Color fundus image, acquired with a NIDEK AFC-230:
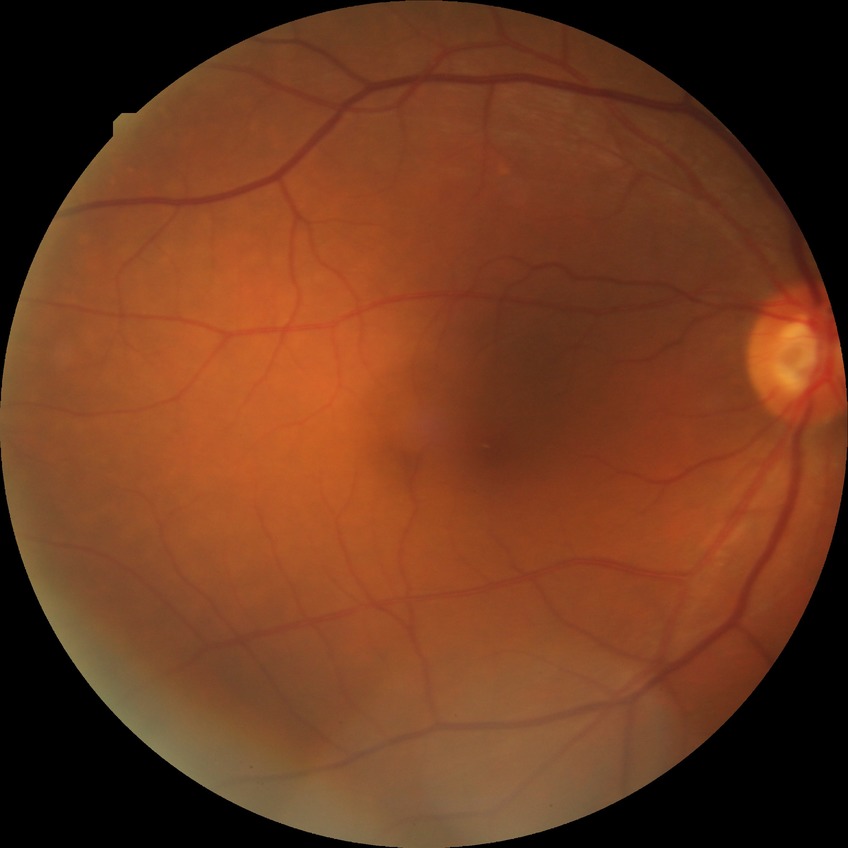 diabetic retinopathy (DR) = no diabetic retinopathy (NDR).